Fundus photo, 2048 x 1536 pixels.
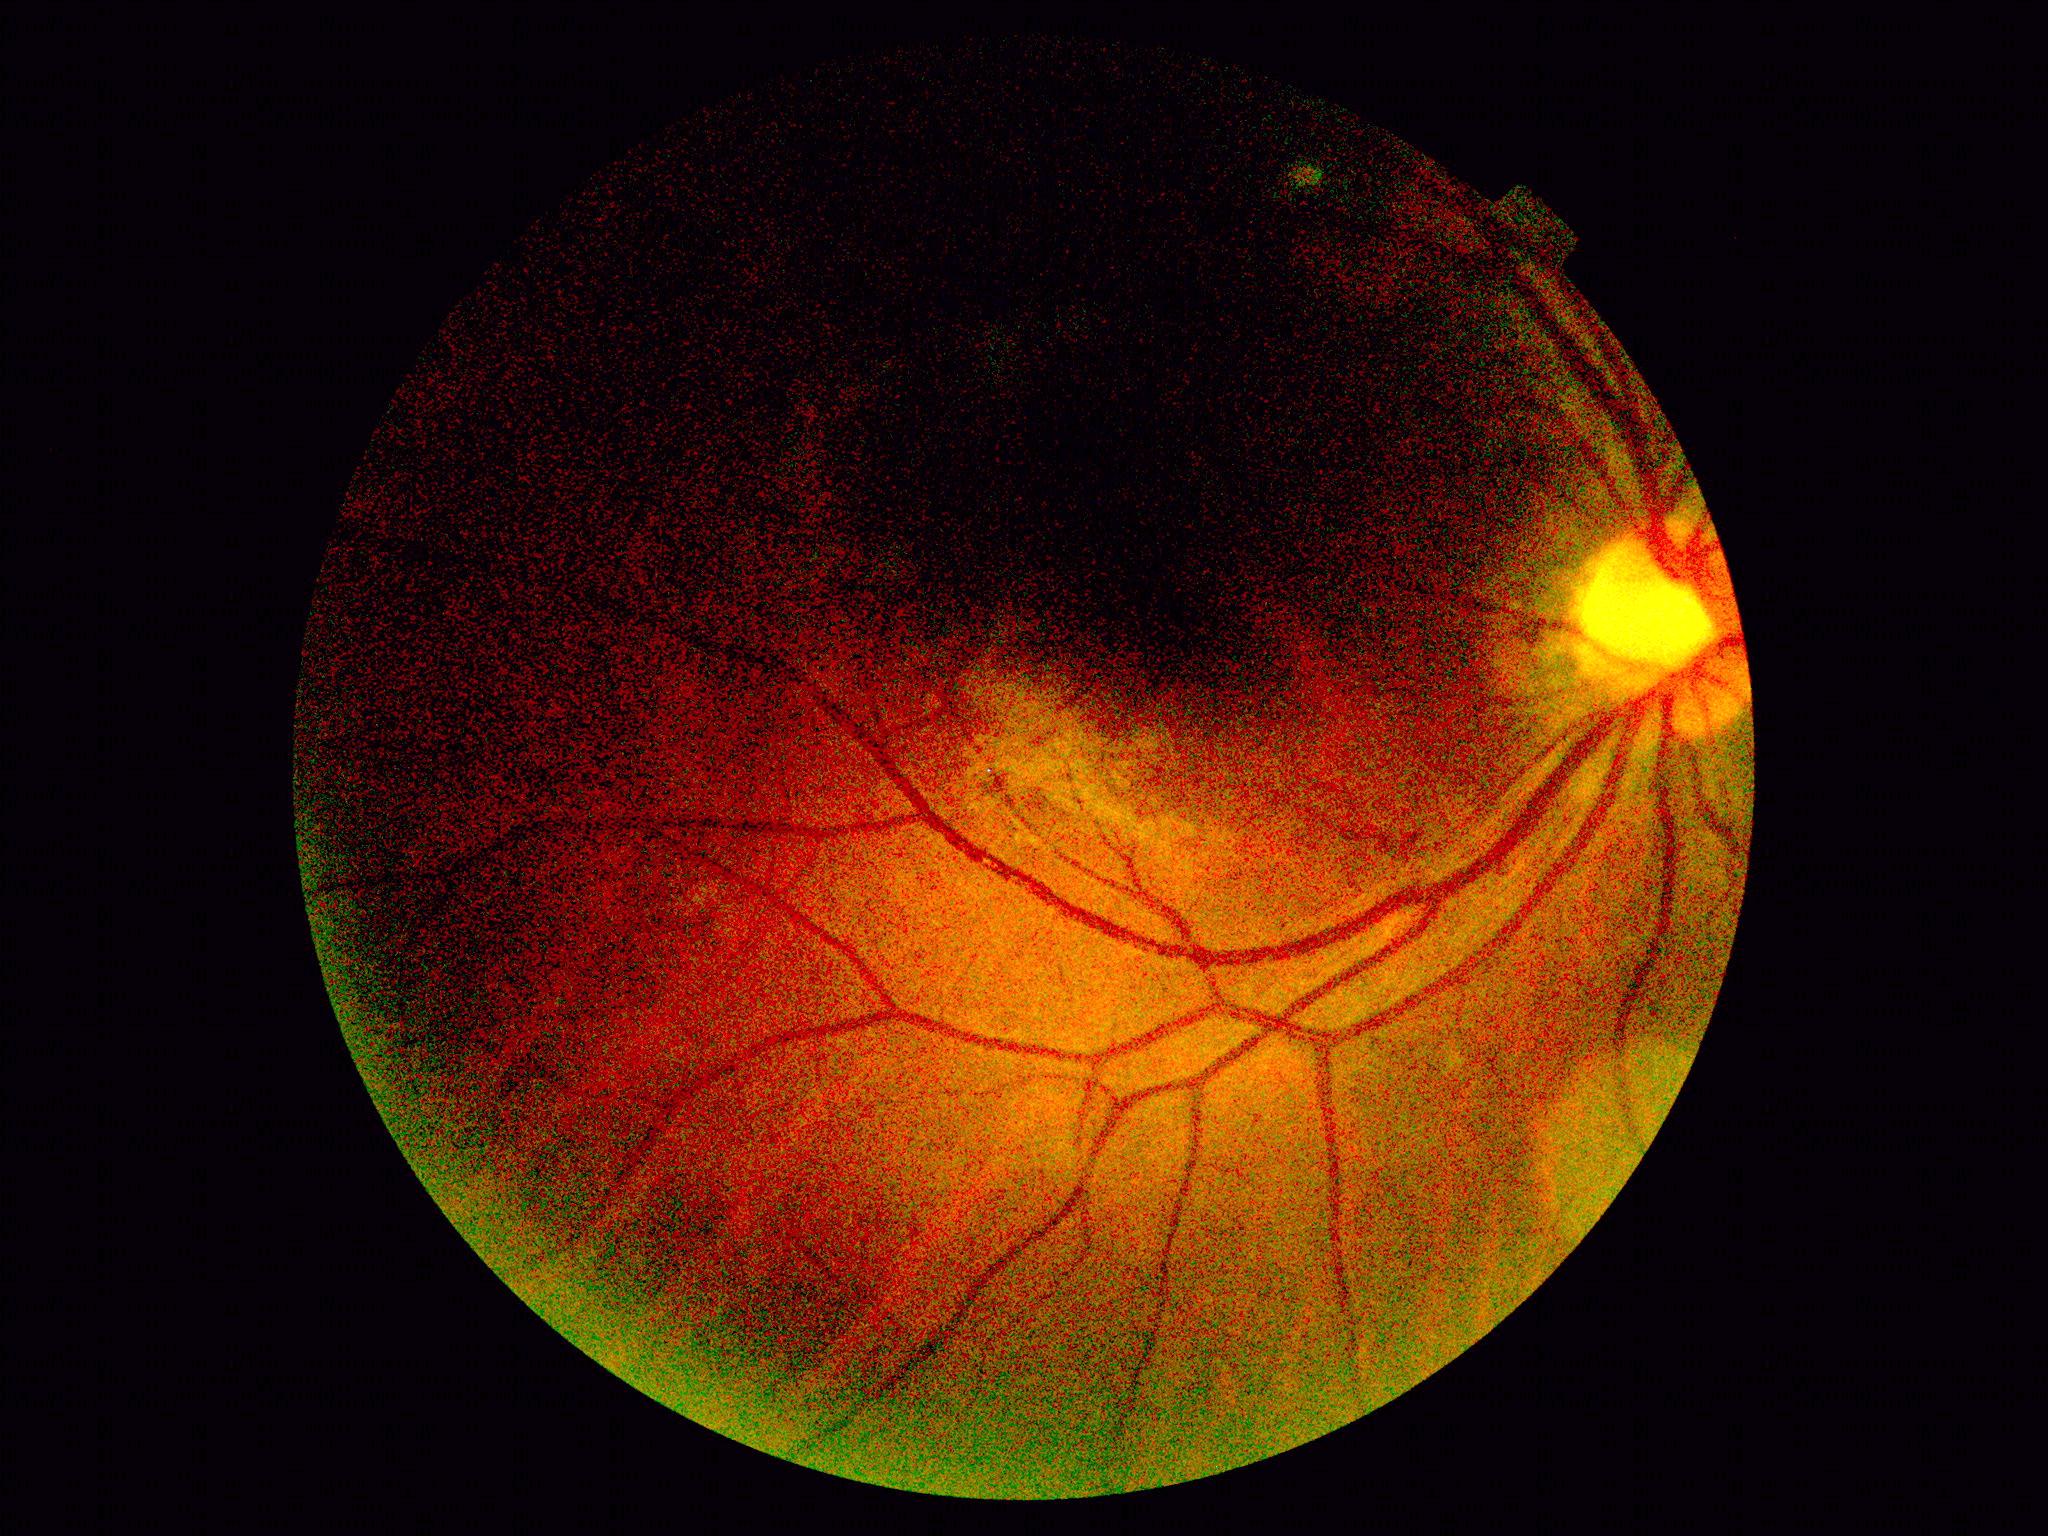 DR stage is ungradable due to poor image quality.
Quality too poor to assess for DR.